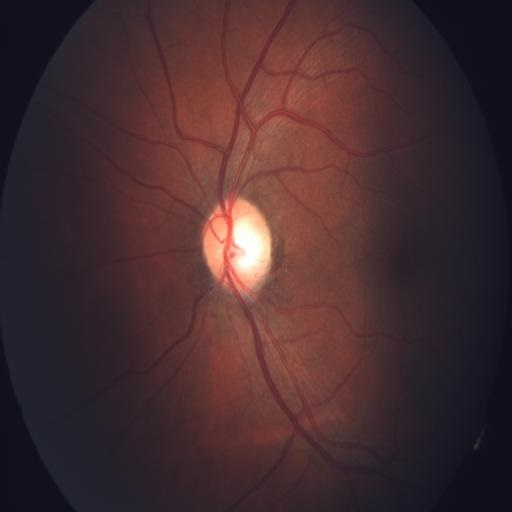

The image shows optic disc cupping.